FOV: 45 degrees — 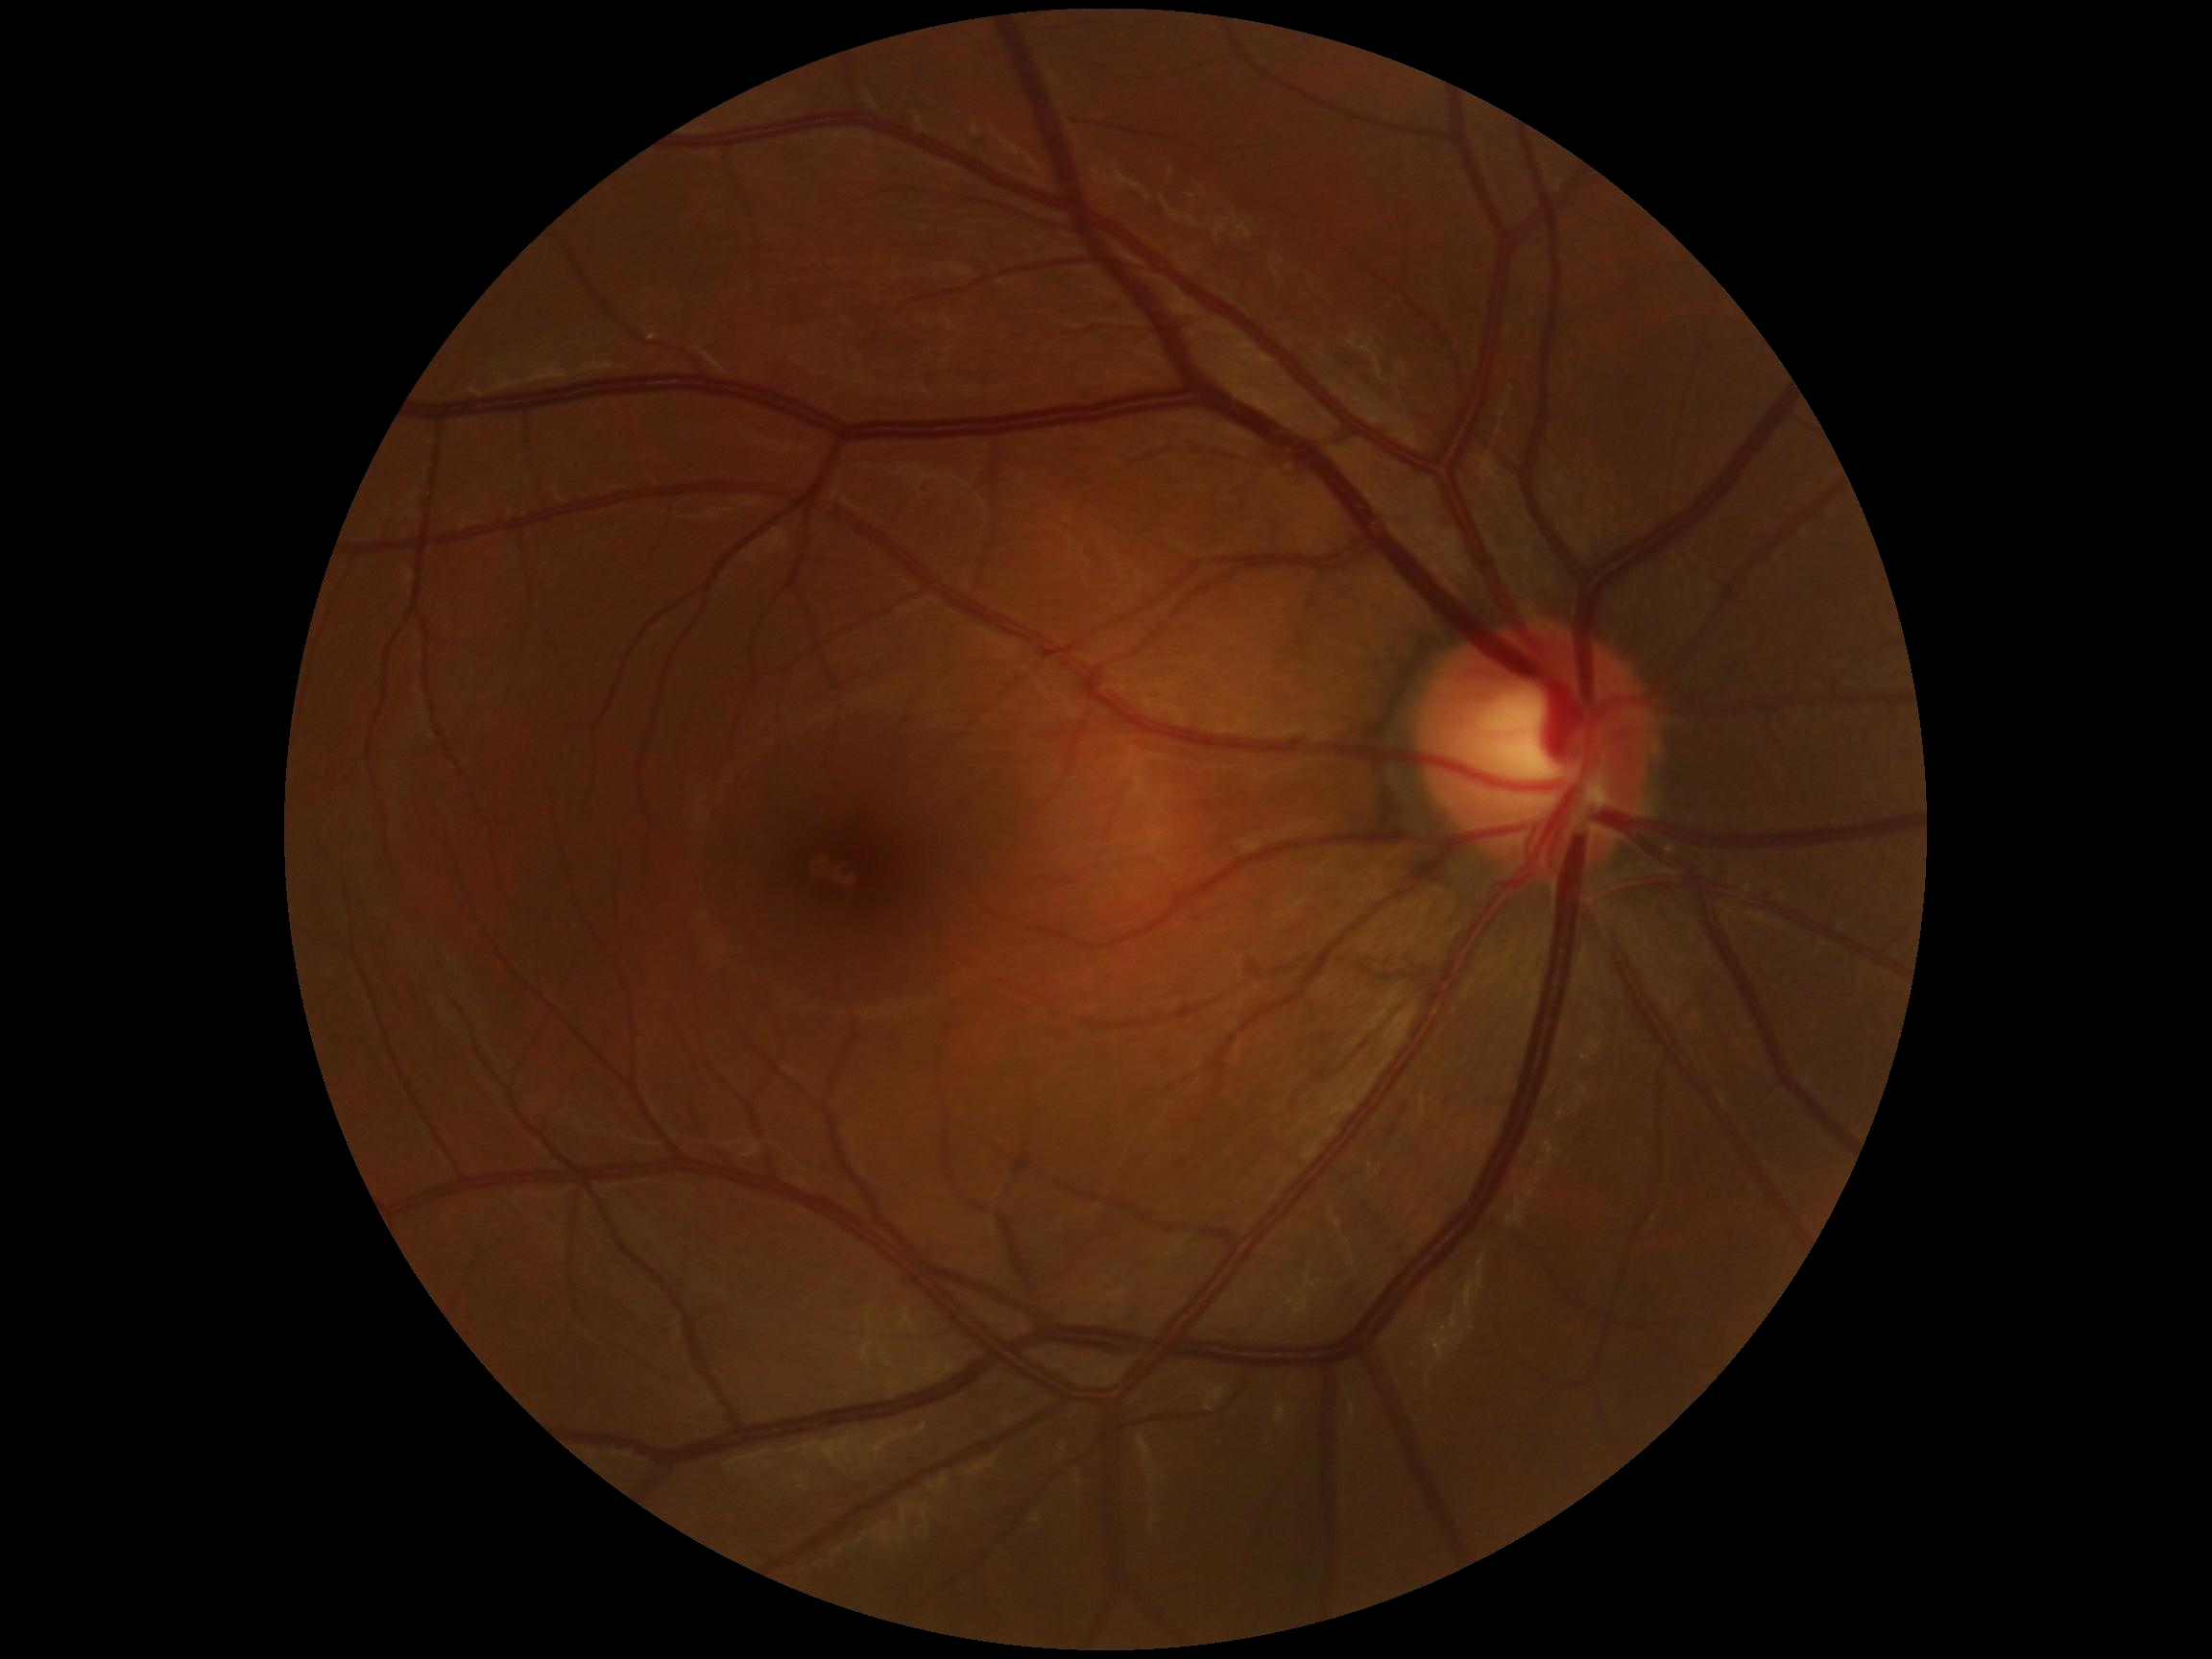

No diabetic retinal disease findings.
DR severity is 0.